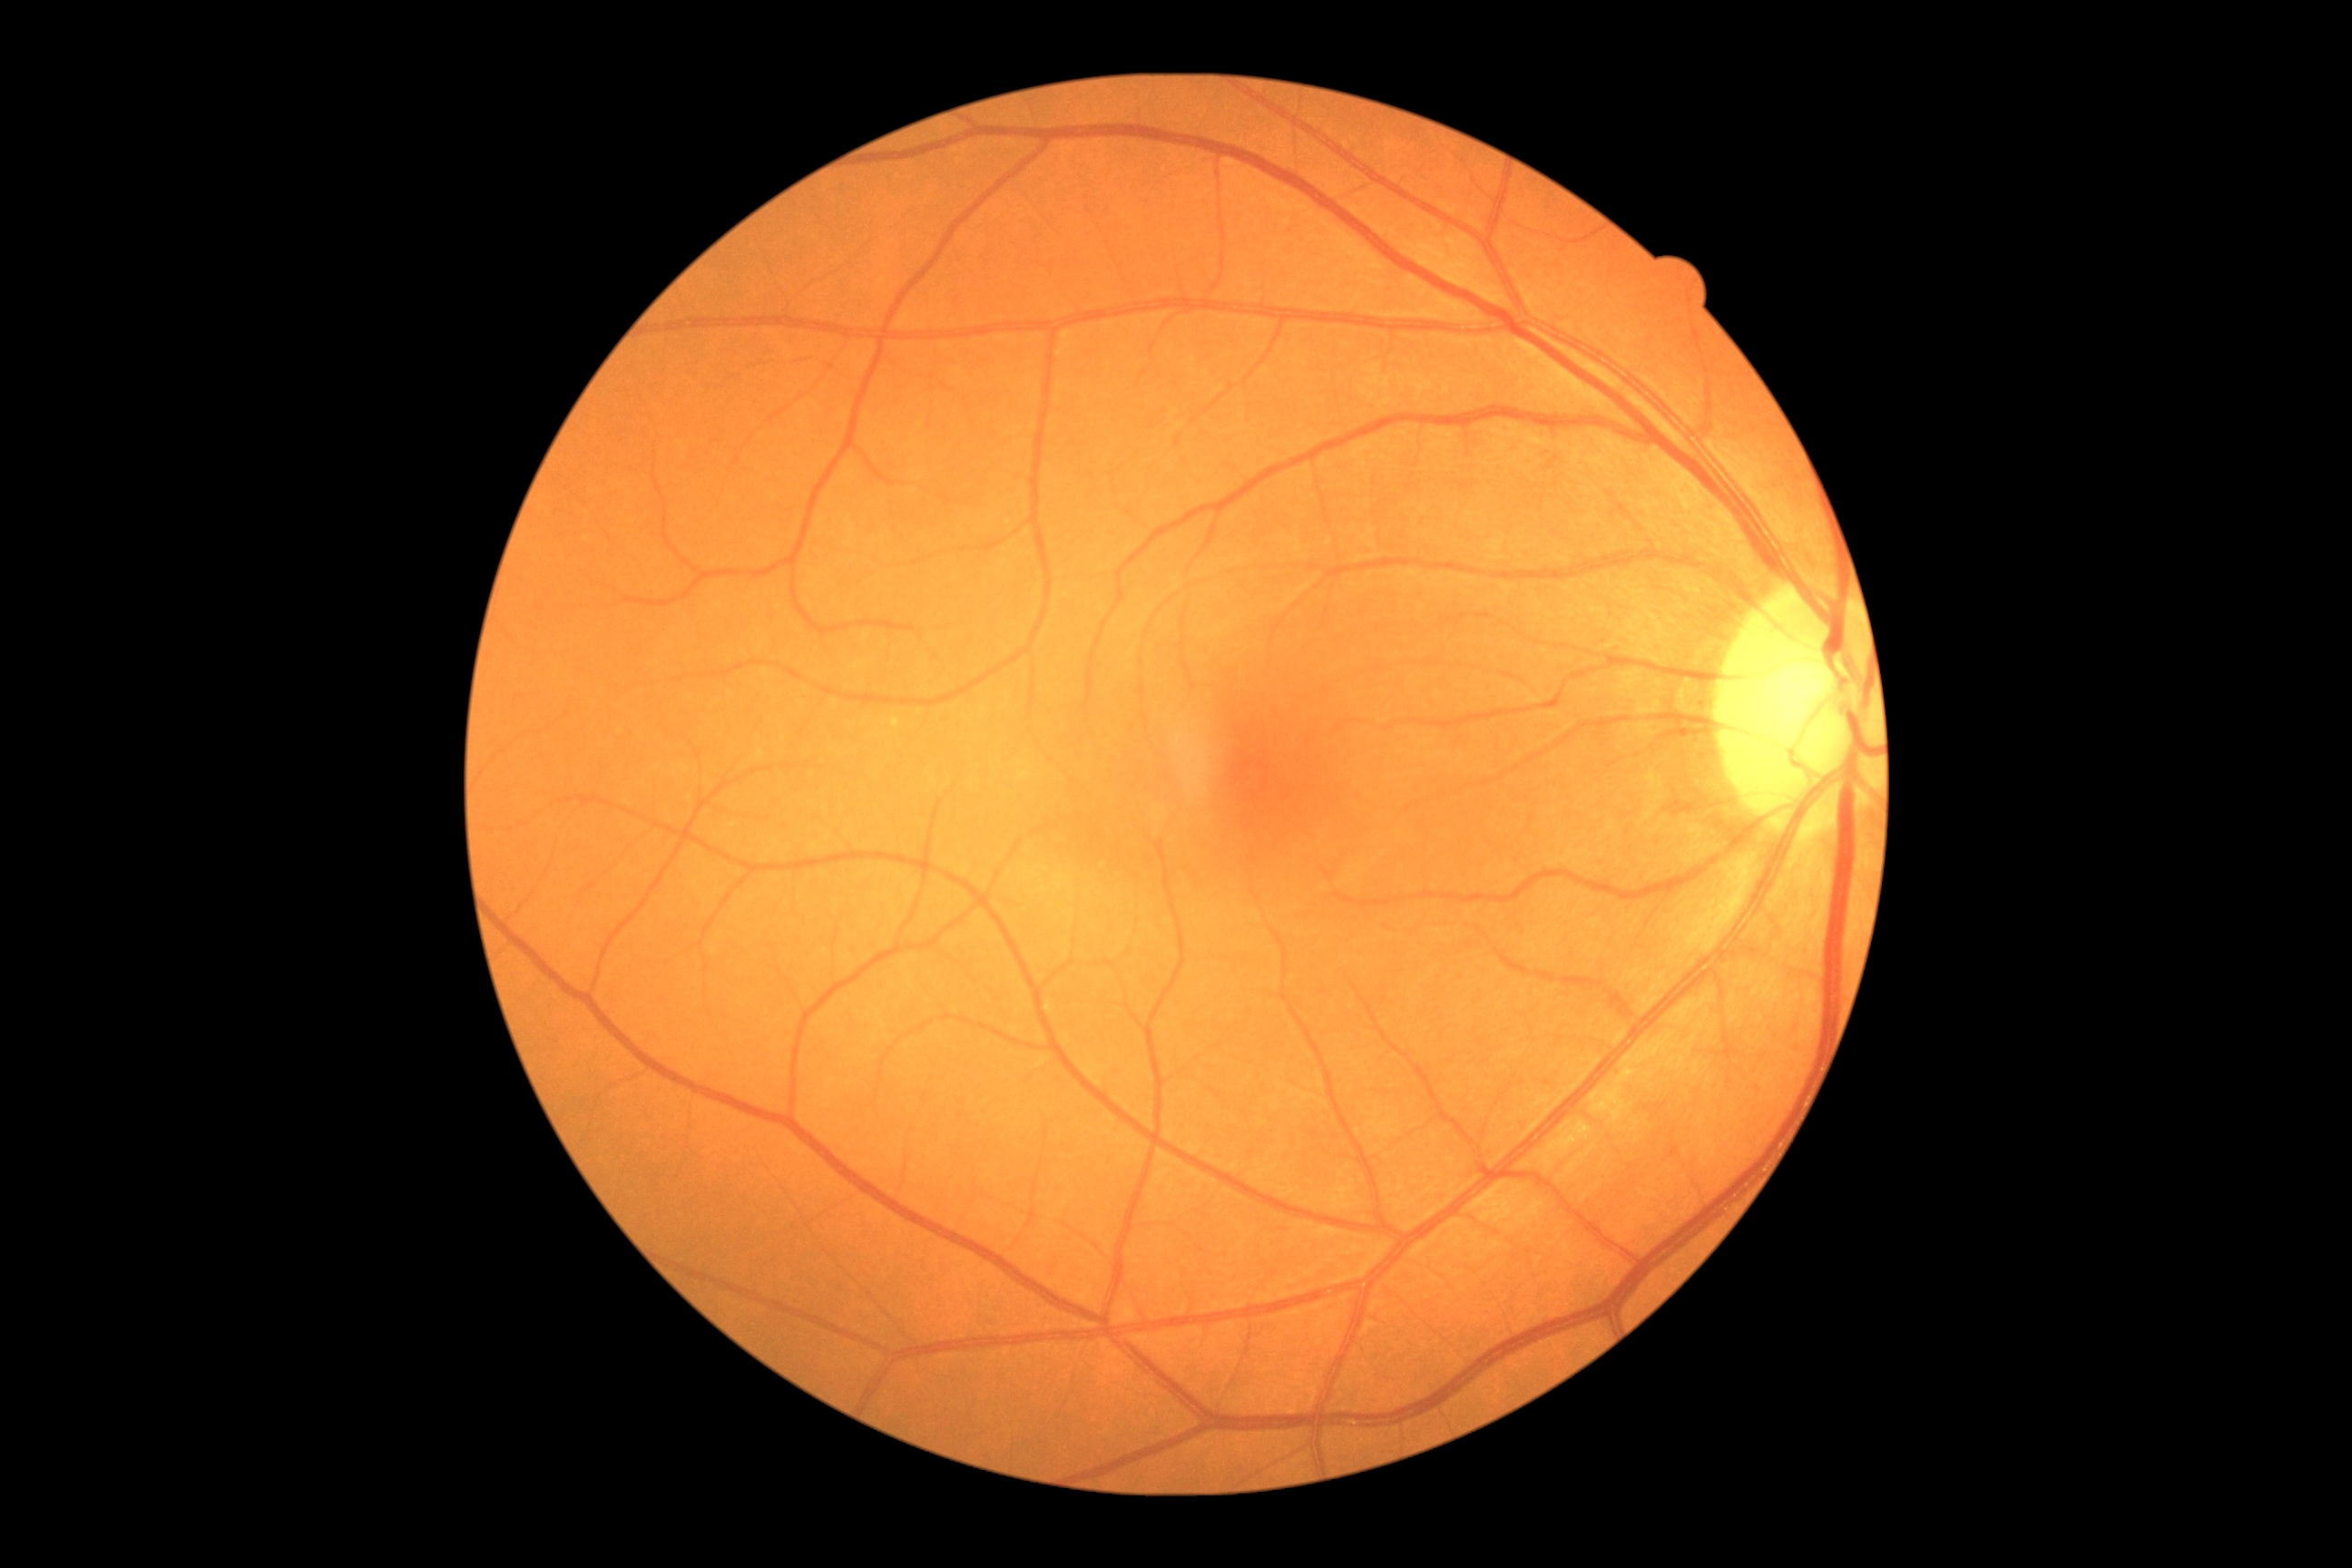

Diabetic retinopathy (DR): 0 — no visible signs of diabetic retinopathy. No apparent diabetic retinopathy.